Captured after pupil dilation.
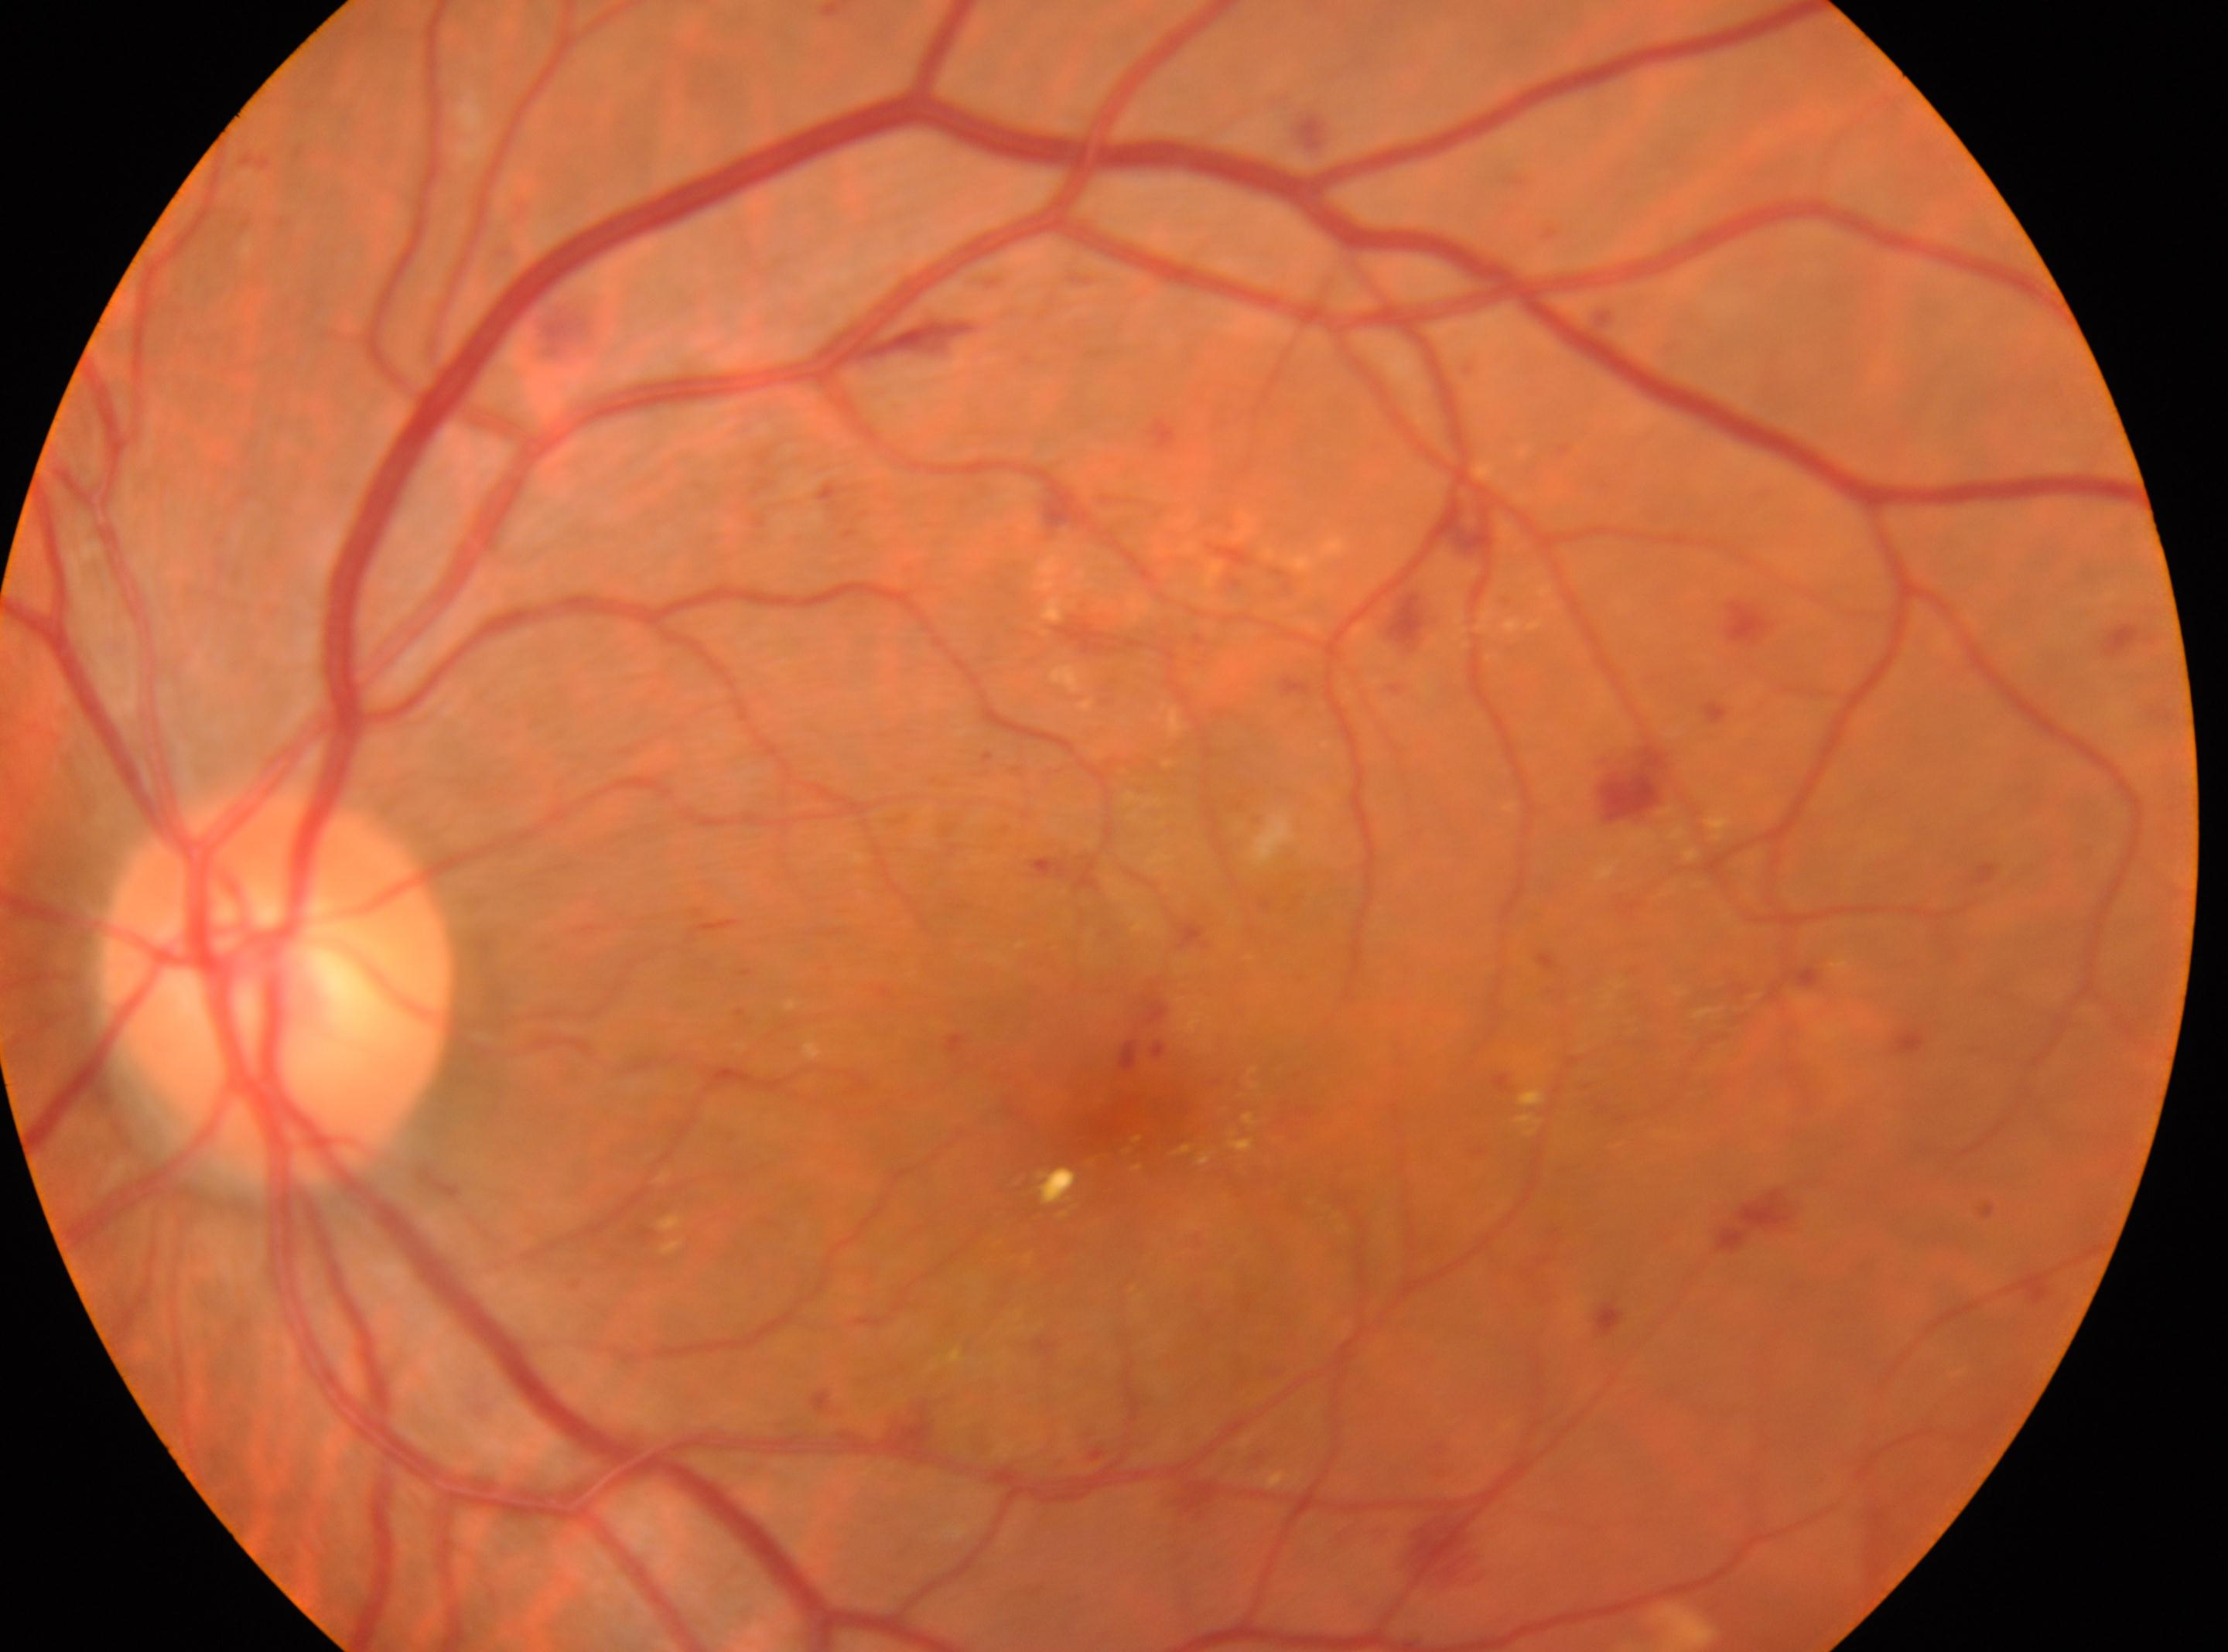

Fovea center: [1129, 1111].
DR stage is severe NPDR (grade 3).
This is the left eye.
Disc center: [278, 988].